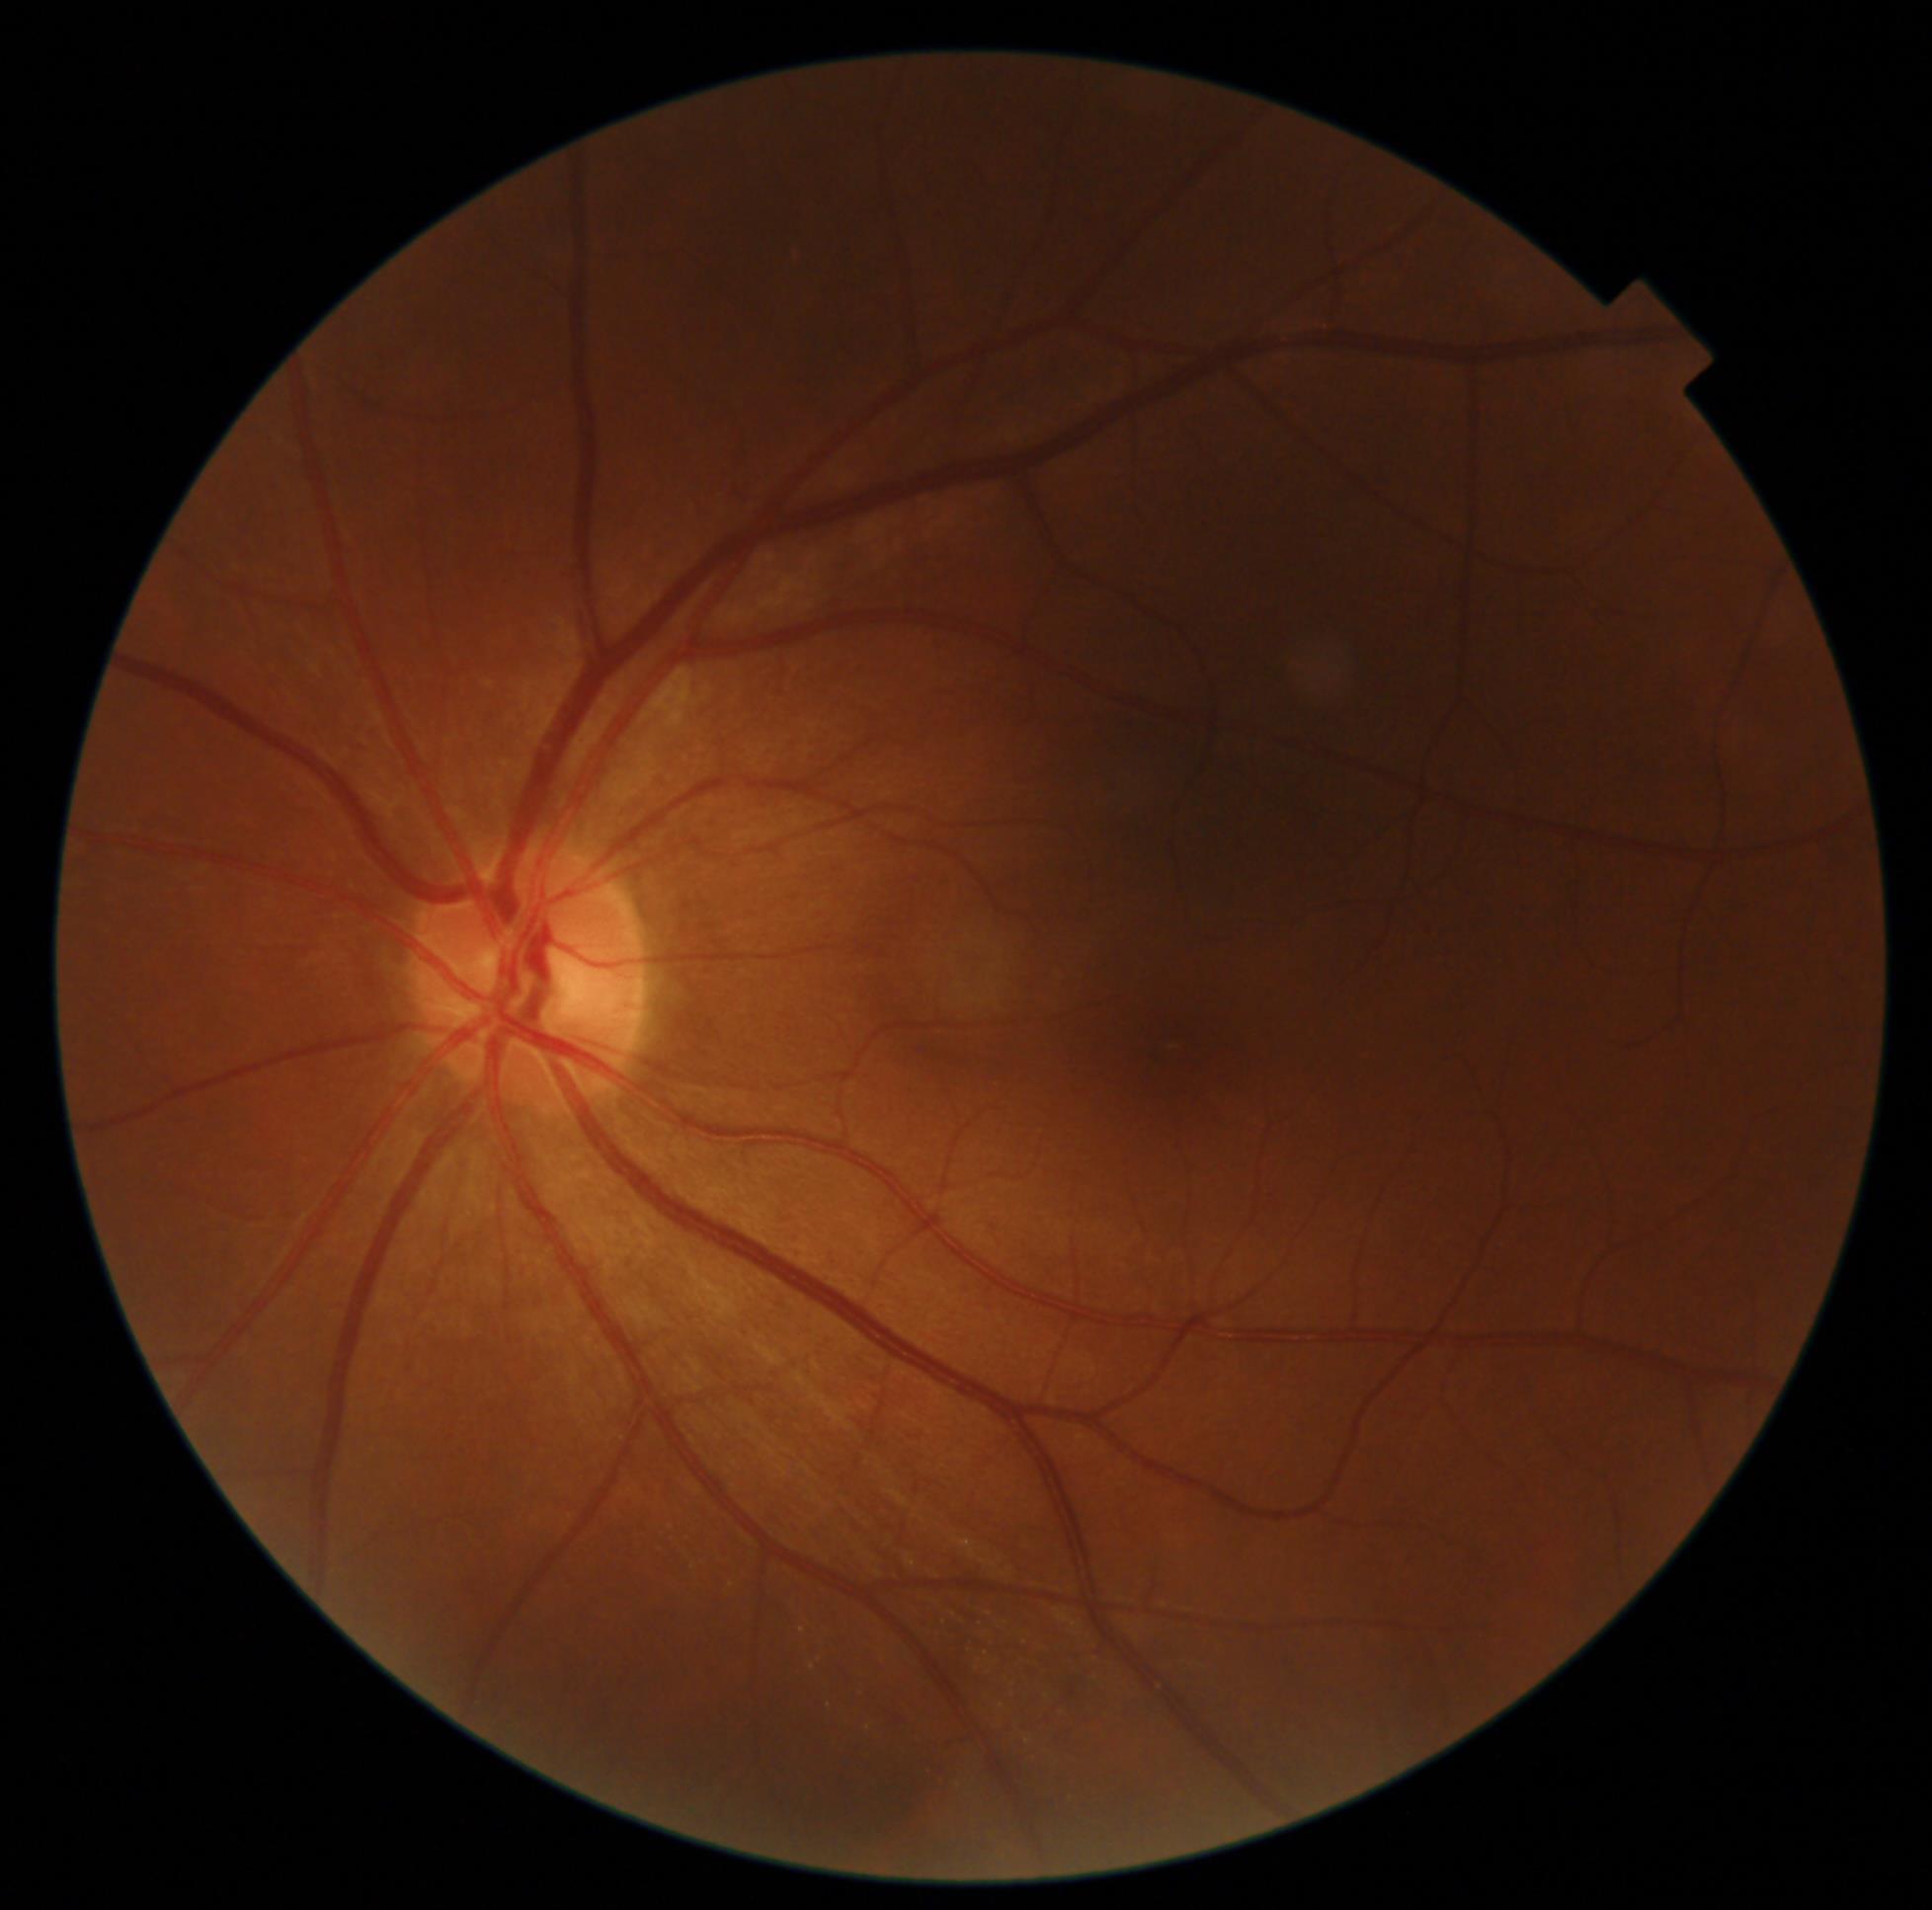

DR grade: 0 (no apparent retinopathy).